FOV: 45 degrees. 848x848px. Davis DR grading
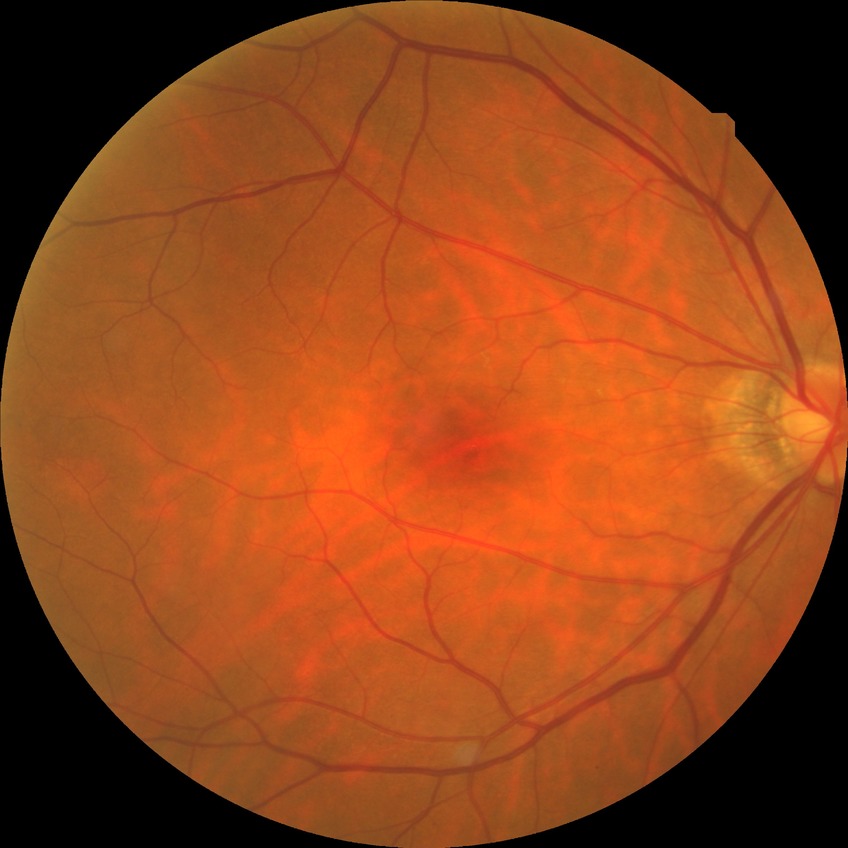 Diabetic retinopathy (DR) is no diabetic retinopathy (NDR).